Color fundus photograph. 2346 by 1568 pixels — 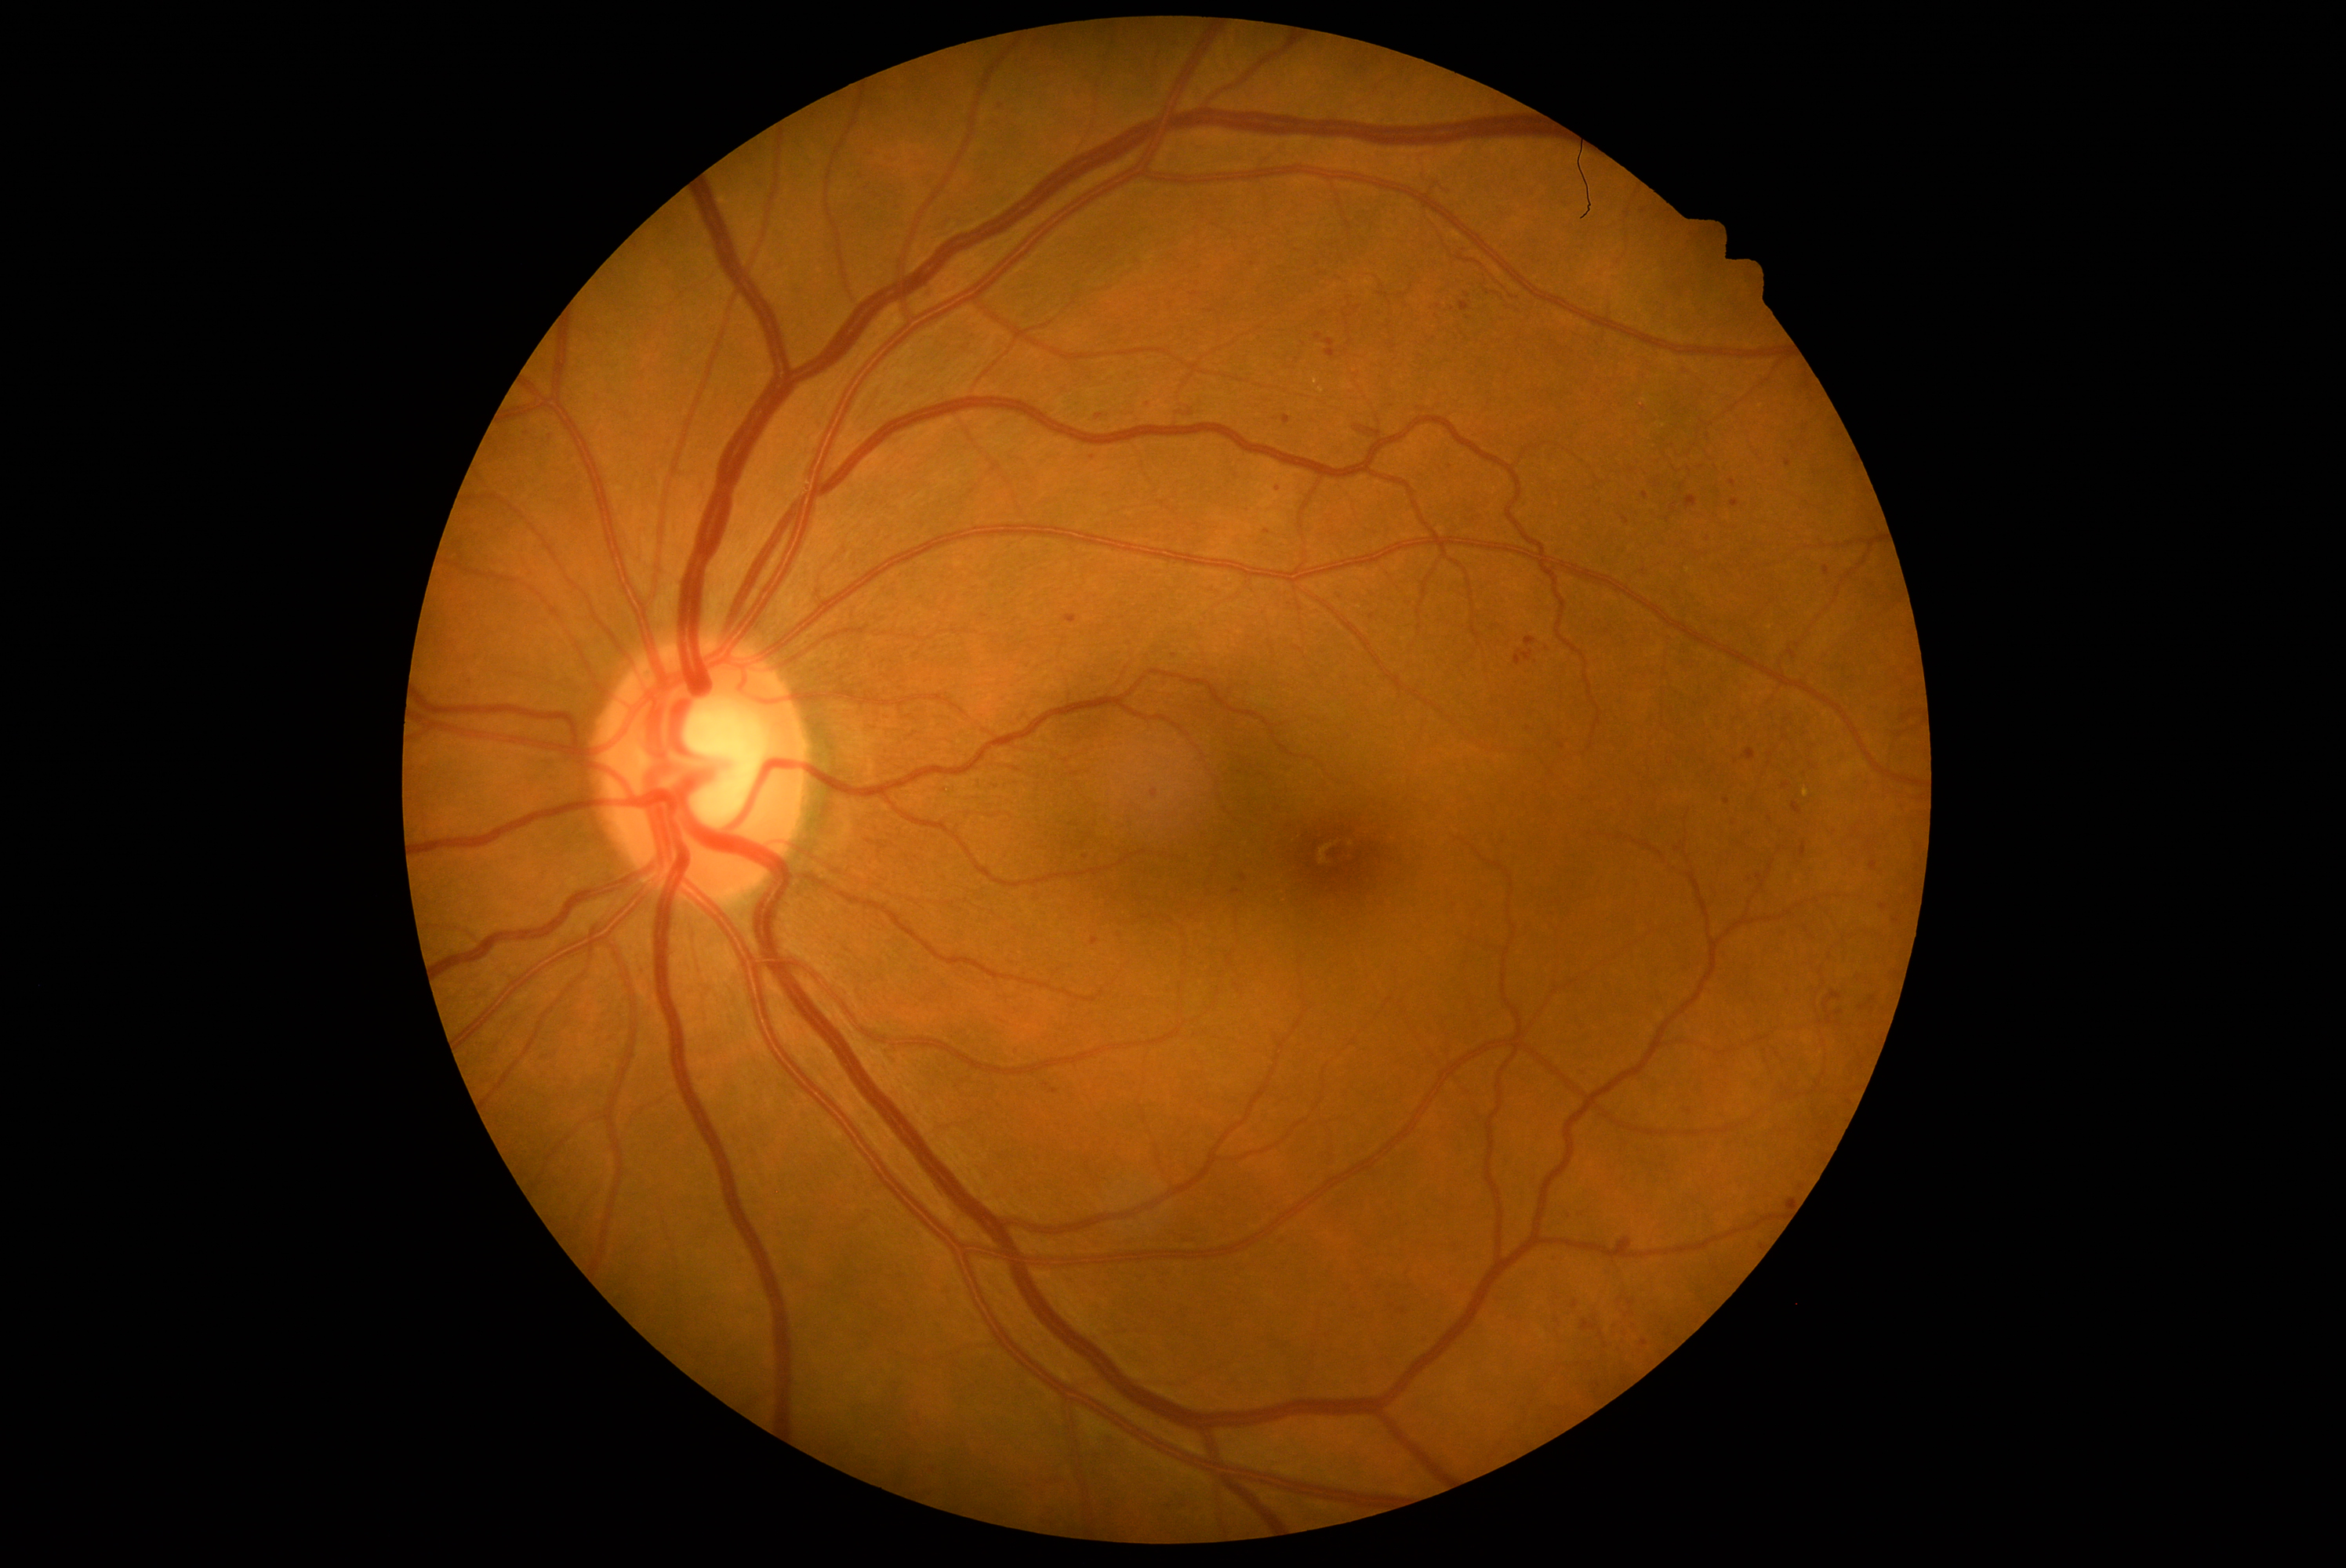

<lesions partial="true">
  <dr_grade>2</dr_grade>
  <ma partial="true">x1=1707 y1=234 x2=1715 y2=239 | x1=1785 y1=873 x2=1796 y2=880 | x1=1028 y1=1153 x2=1042 y2=1166 | x1=1680 y1=1106 x2=1694 y2=1117 | x1=1613 y1=1236 x2=1636 y2=1252 | x1=1680 y1=965 x2=1691 y2=975 | x1=1823 y1=567 x2=1829 y2=576 | x1=1878 y1=869 x2=1886 y2=879 | x1=1447 y1=1266 x2=1458 y2=1277 | x1=1892 y1=918 x2=1900 y2=924 | x1=1782 y1=985 x2=1792 y2=998 | x1=1088 y1=1451 x2=1103 y2=1465 | x1=1575 y1=1208 x2=1588 y2=1219</ma>
  <ma_small_approx>Point(813, 120) | Point(1438, 307) | Point(1253, 264) | Point(1643, 408) | Point(877, 196) | Point(1605, 1346)</ma_small_approx>
</lesions>